CFP:
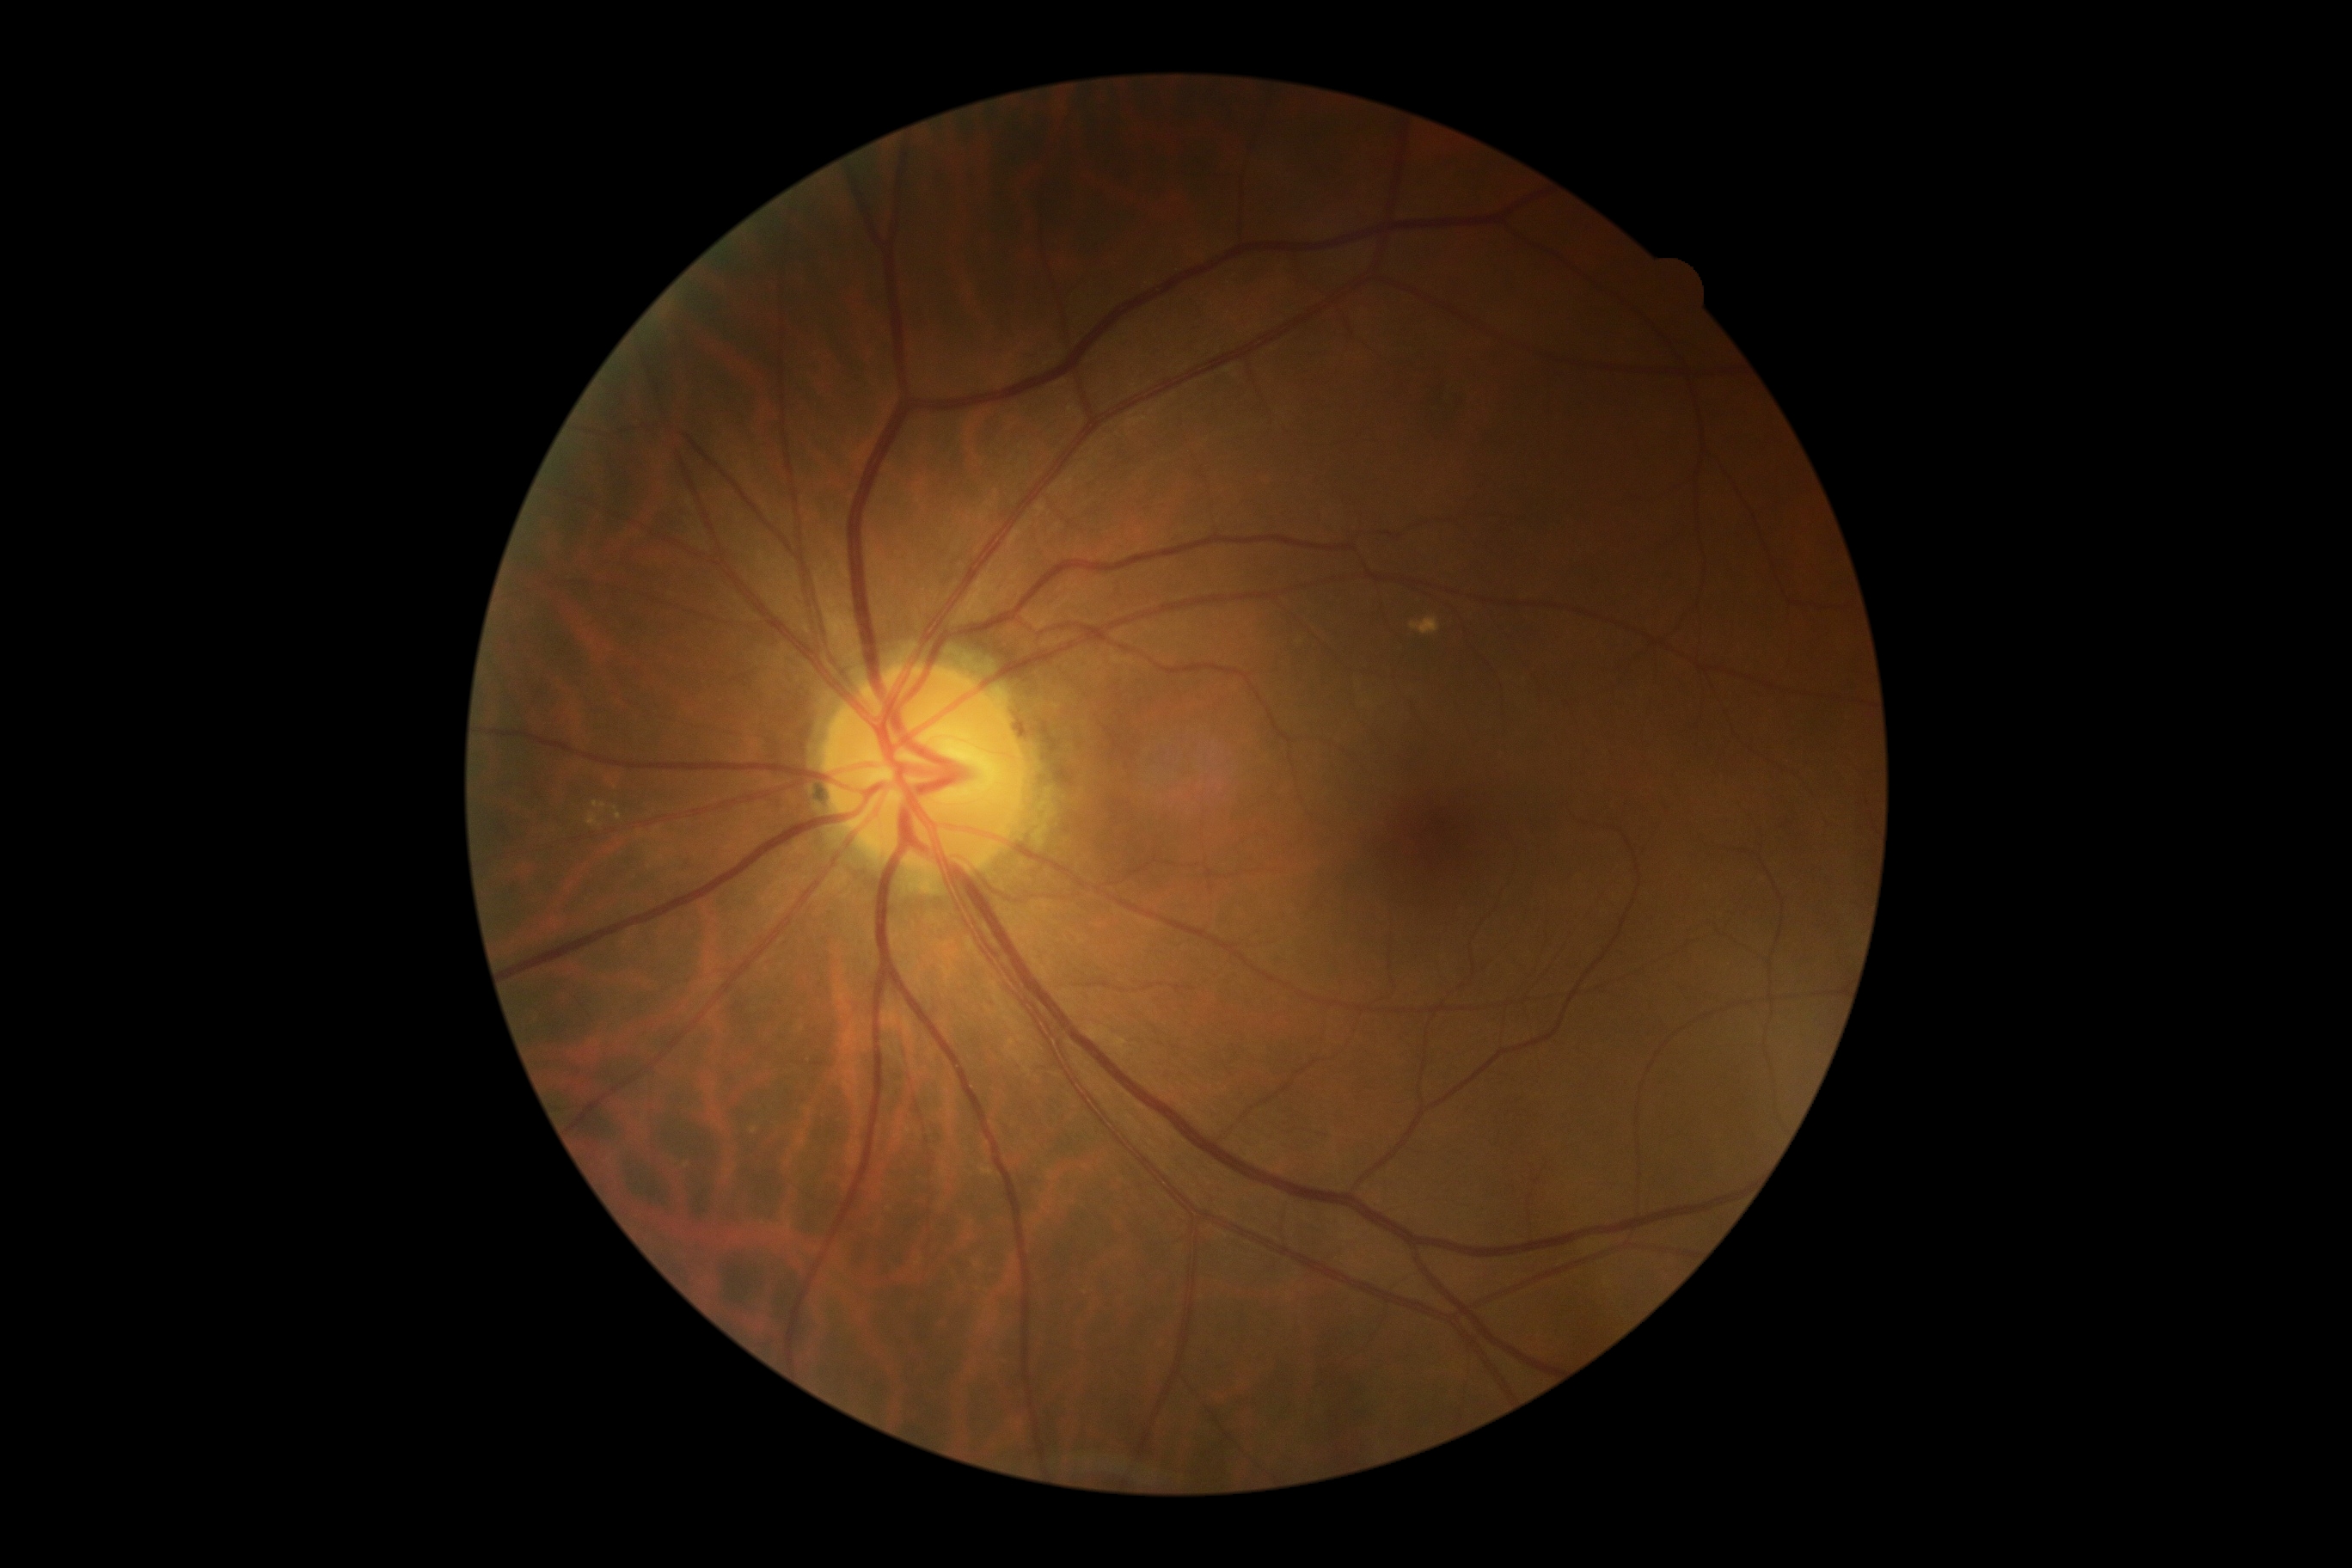
DR class = non-proliferative diabetic retinopathy, DR severity = 2/4.